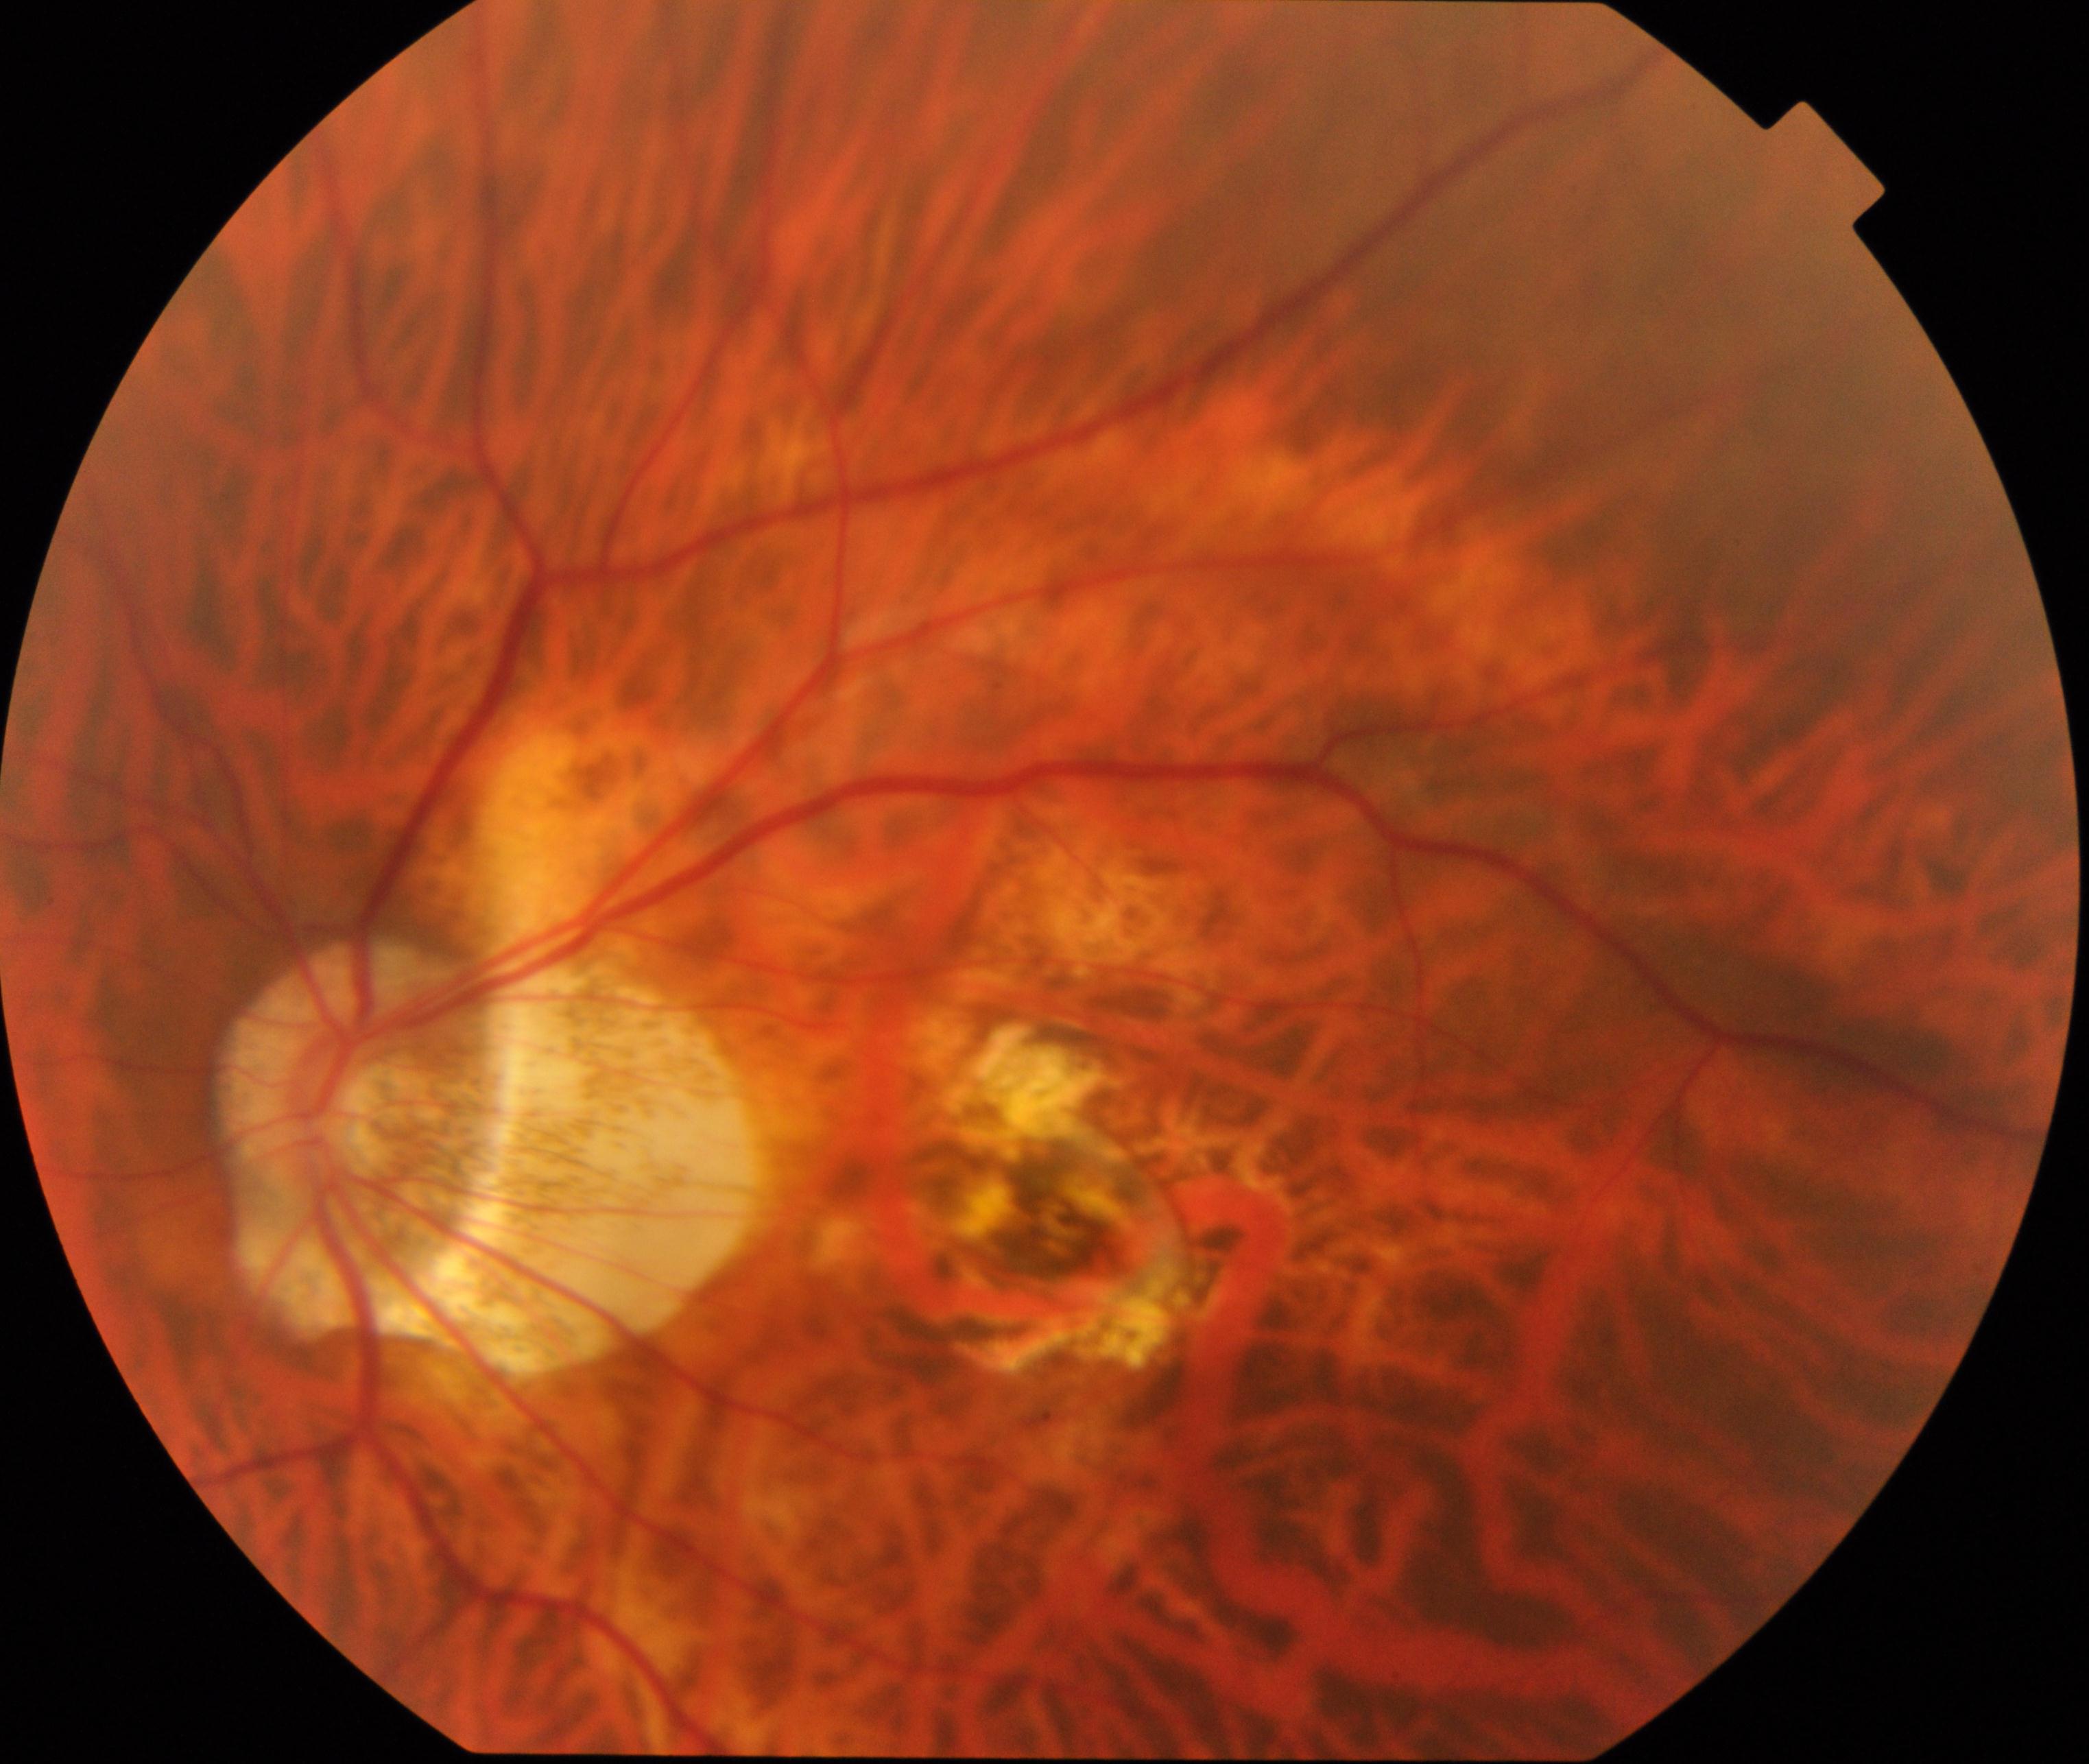 Fundus image consistent with pathological myopia.